NIDEK AFC-230 fundus camera — 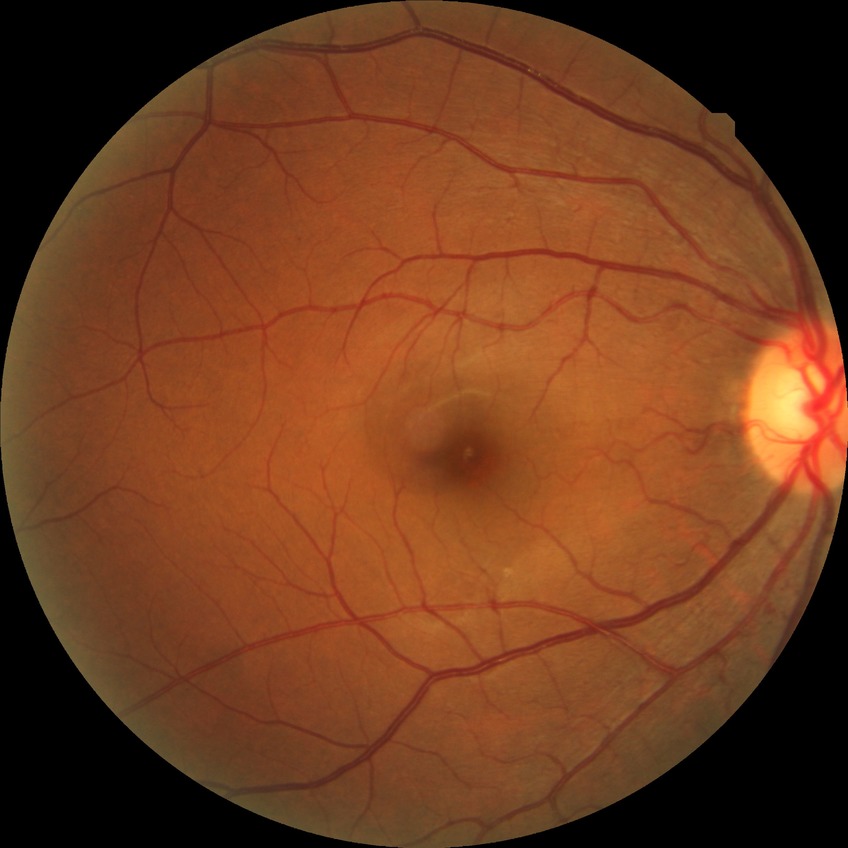 Davis stage=SDR.